45° field of view — 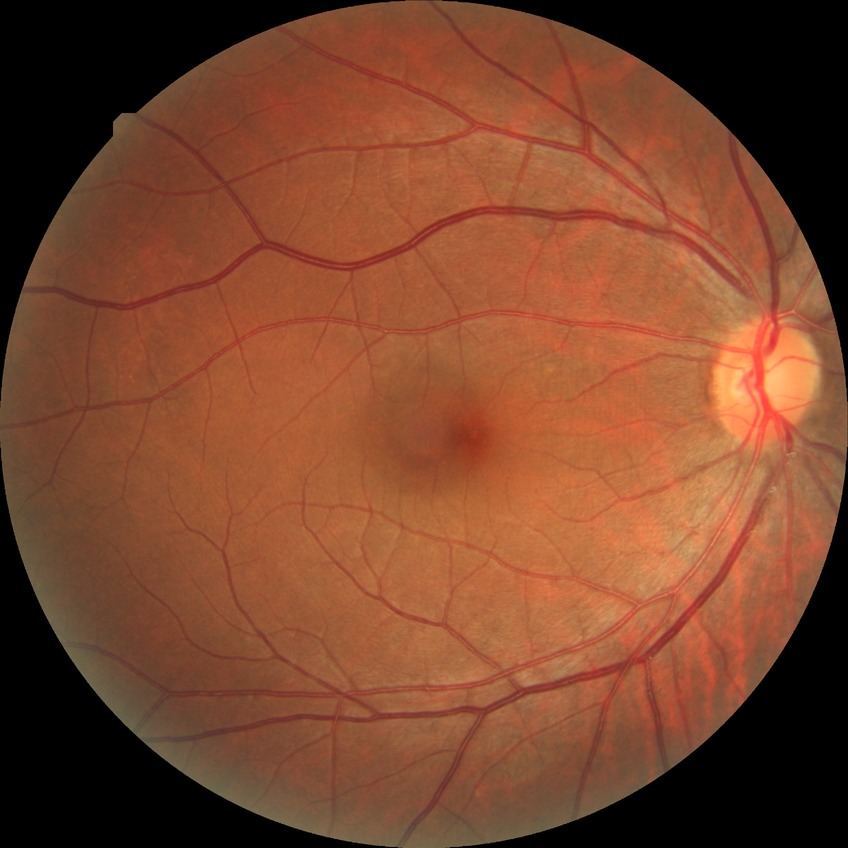 Diabetic retinopathy stage is no diabetic retinopathy.